2212x1659.
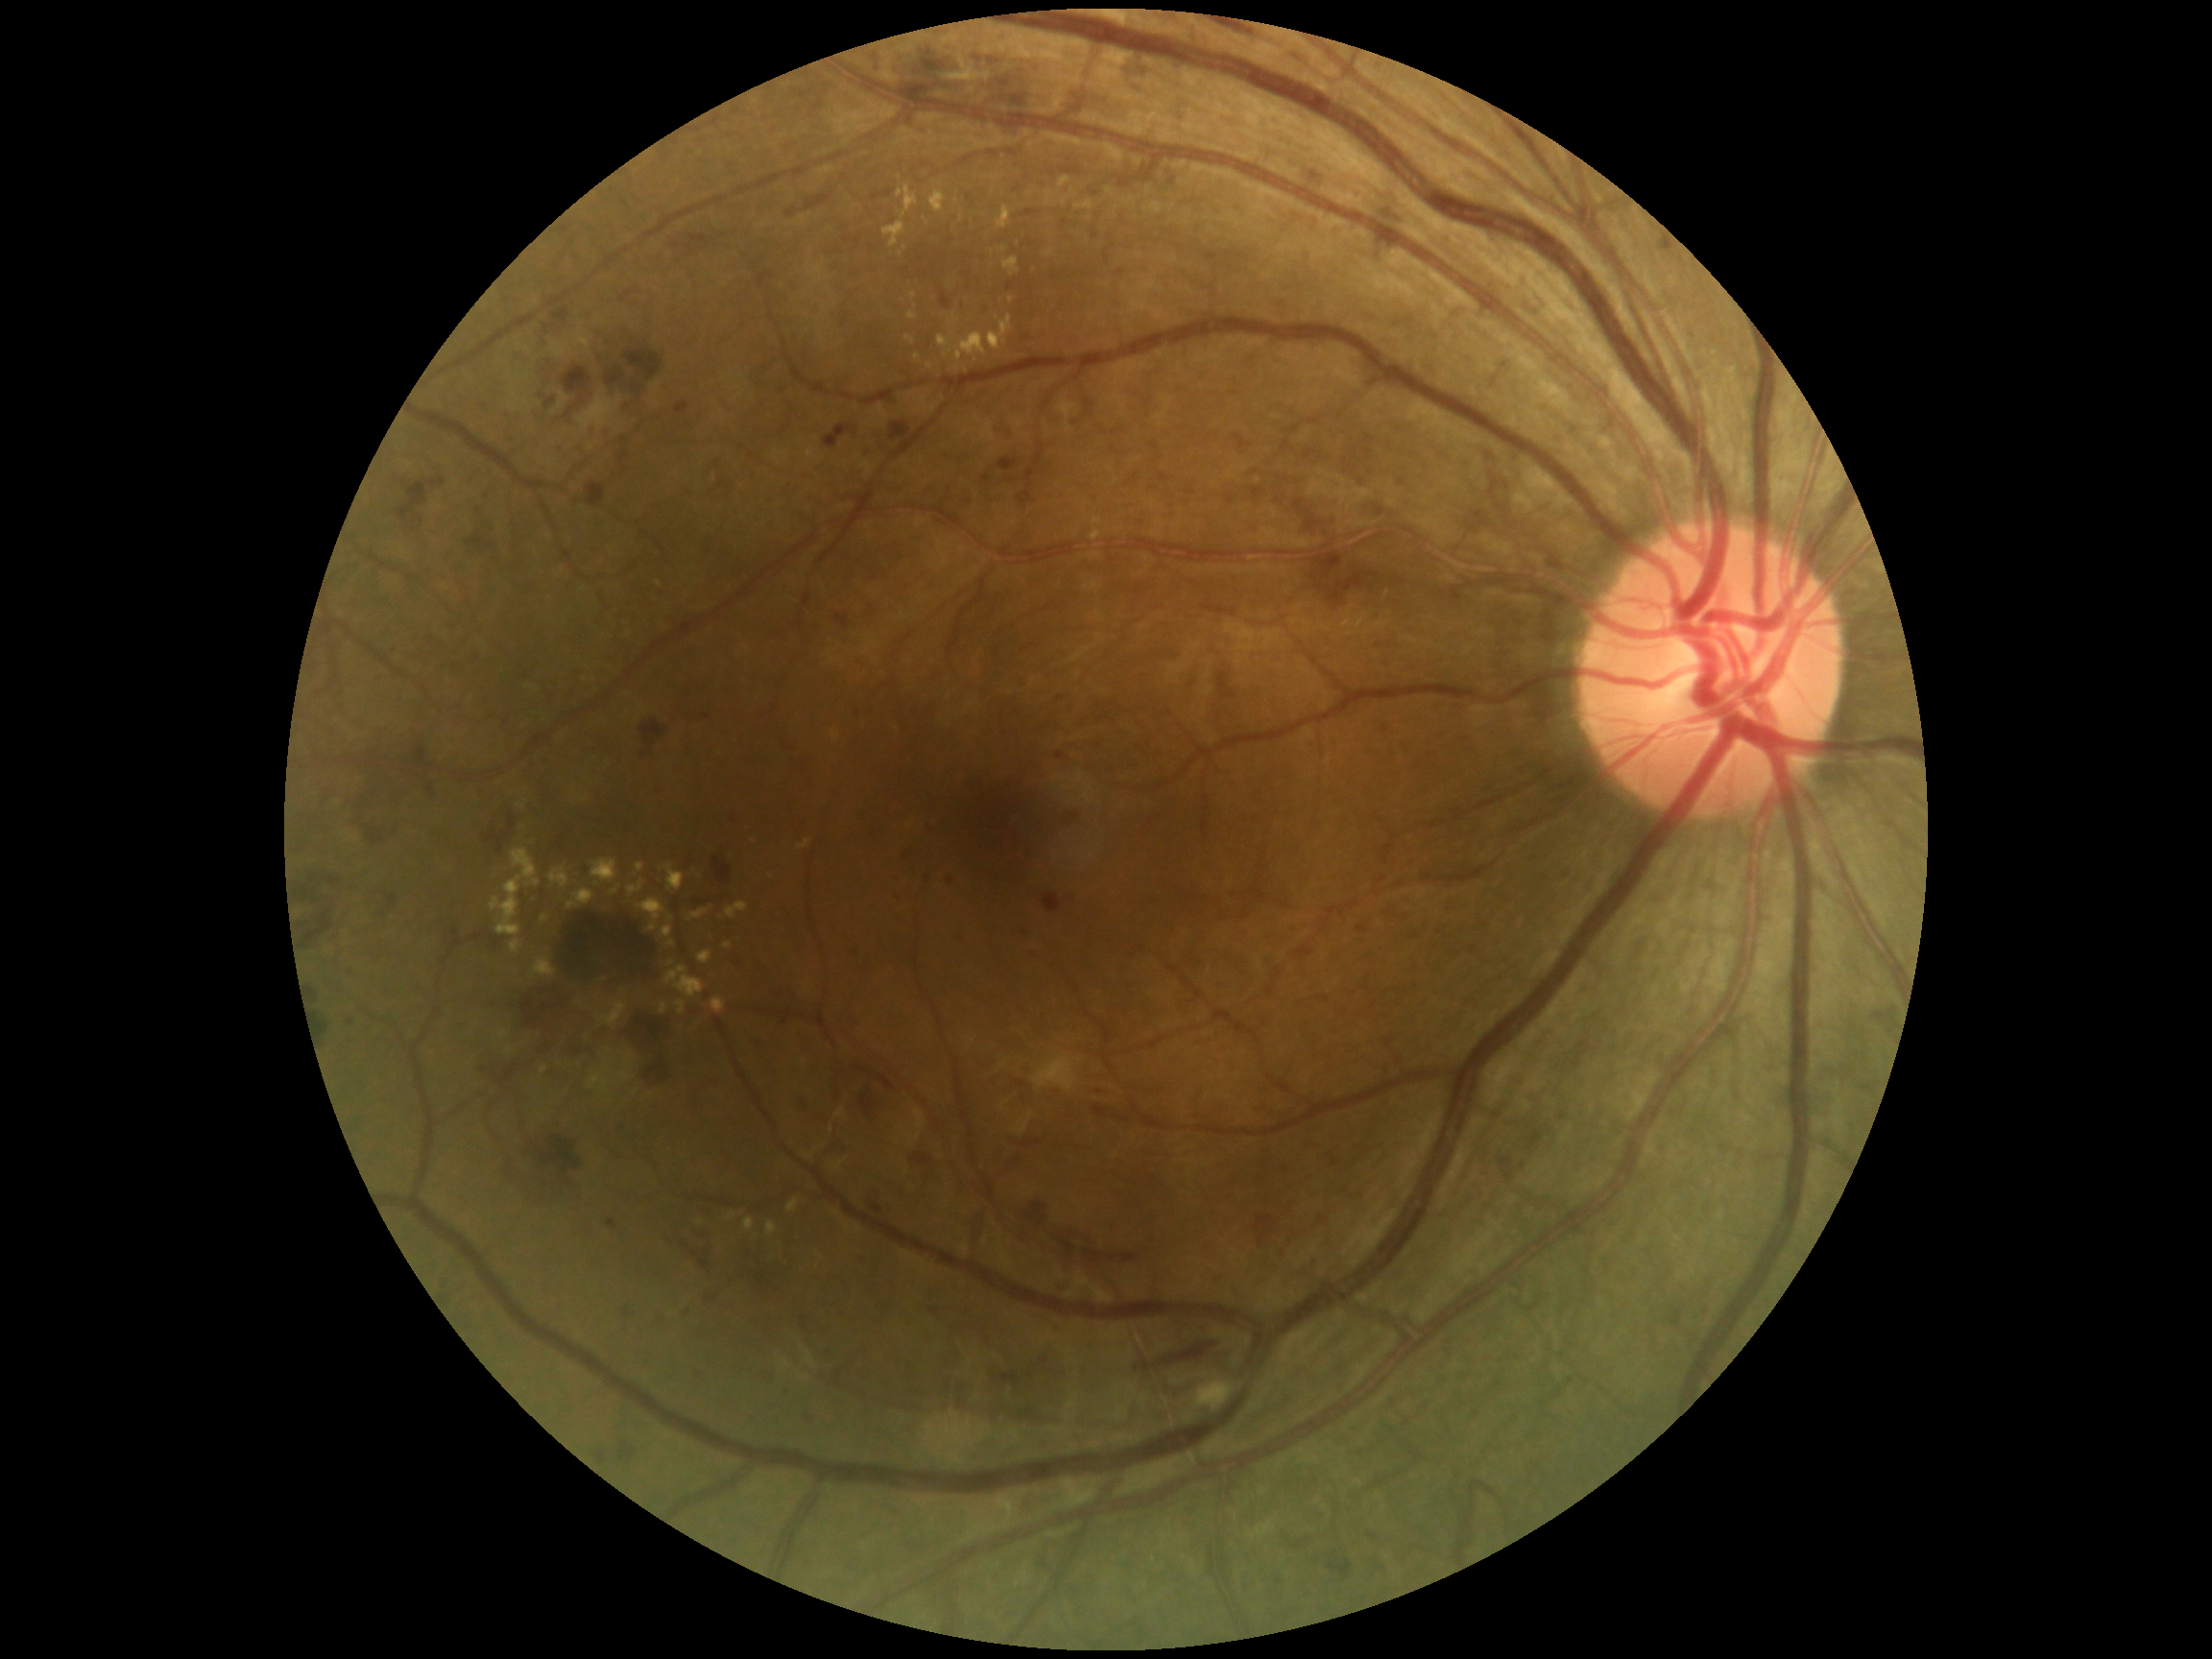
Diabetic retinopathy severity is 3/4
Lesions identified (partial list):
hemorrhages (partial): BBox(911, 1155, 934, 1166); BBox(1218, 674, 1236, 701); BBox(1122, 59, 1146, 89); BBox(430, 476, 445, 488); BBox(354, 775, 400, 844); BBox(626, 350, 664, 381); BBox(509, 815, 517, 831); BBox(529, 1126, 581, 1173); BBox(857, 1258, 867, 1266); BBox(693, 1250, 710, 1271); BBox(1314, 553, 1343, 582); BBox(386, 894, 397, 913); BBox(1329, 1560, 1353, 1577); BBox(1064, 810, 1077, 831); BBox(901, 80, 970, 100); BBox(804, 195, 831, 214); BBox(660, 1311, 675, 1334)
Small hemorrhages near (992, 62)